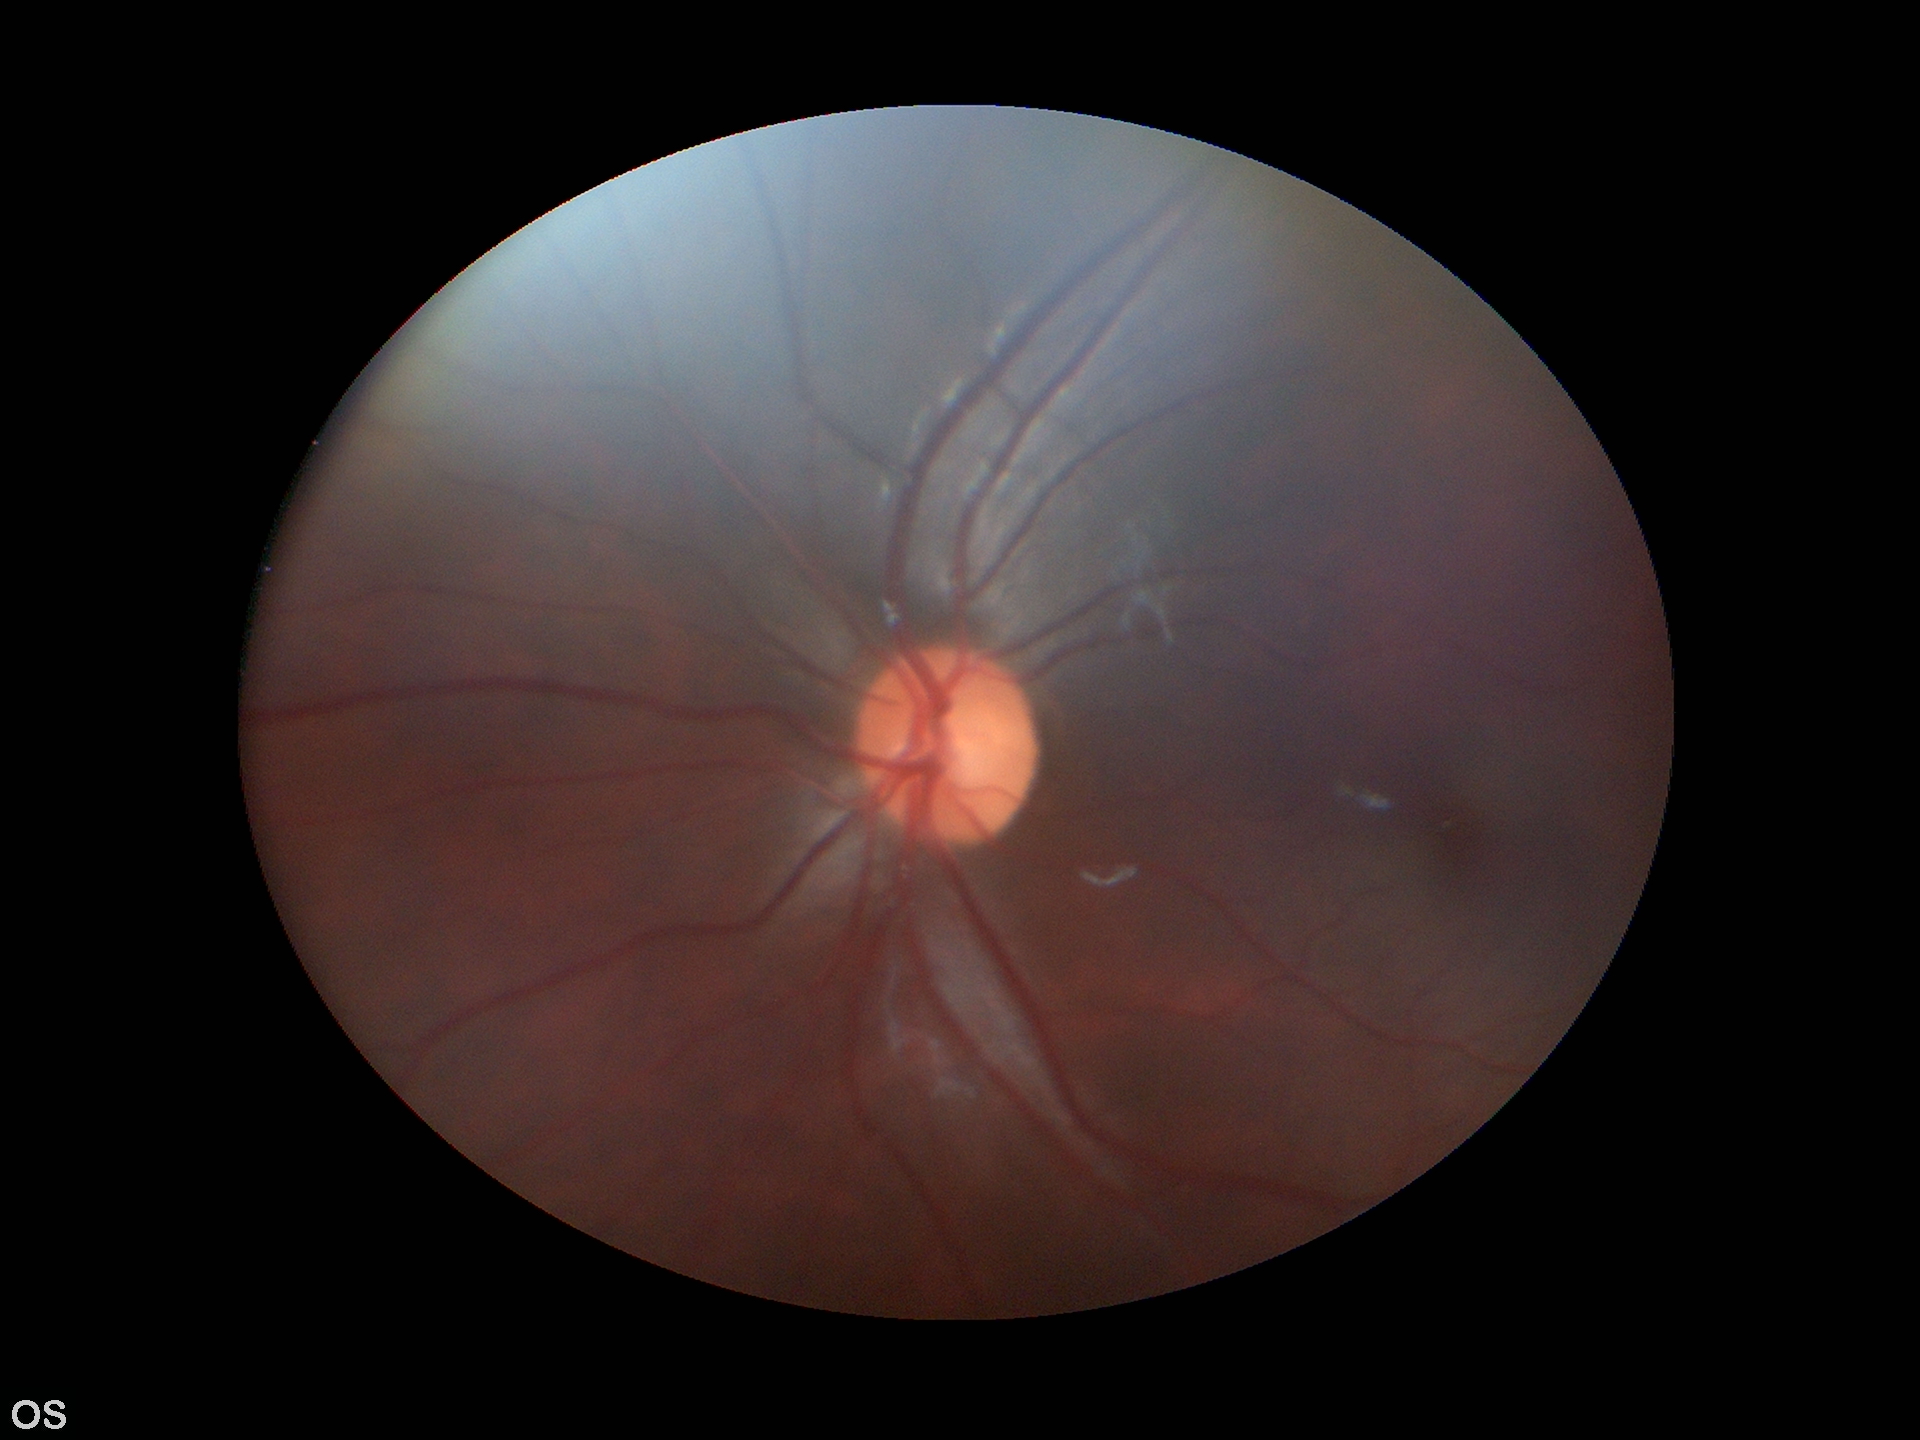

Glaucoma decision: no suspicious findings. Vertical C/D ratio (VCDR): 0.52. Area cup-to-disc ratio (ACDR) of 0.28. Horizontal cup-to-disc ratio (HCDR) is 0.52.